Retinal fundus photograph:
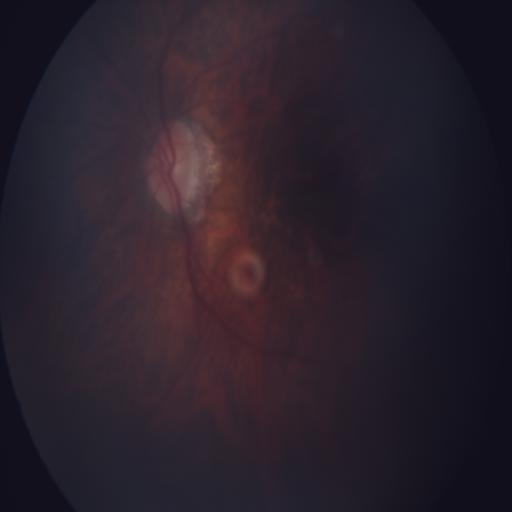
Findings consistent with myopia (MYA), tilted disc (TD) & tessellation (TSLN).